2048x1536, 45° FOV, fundus photo:
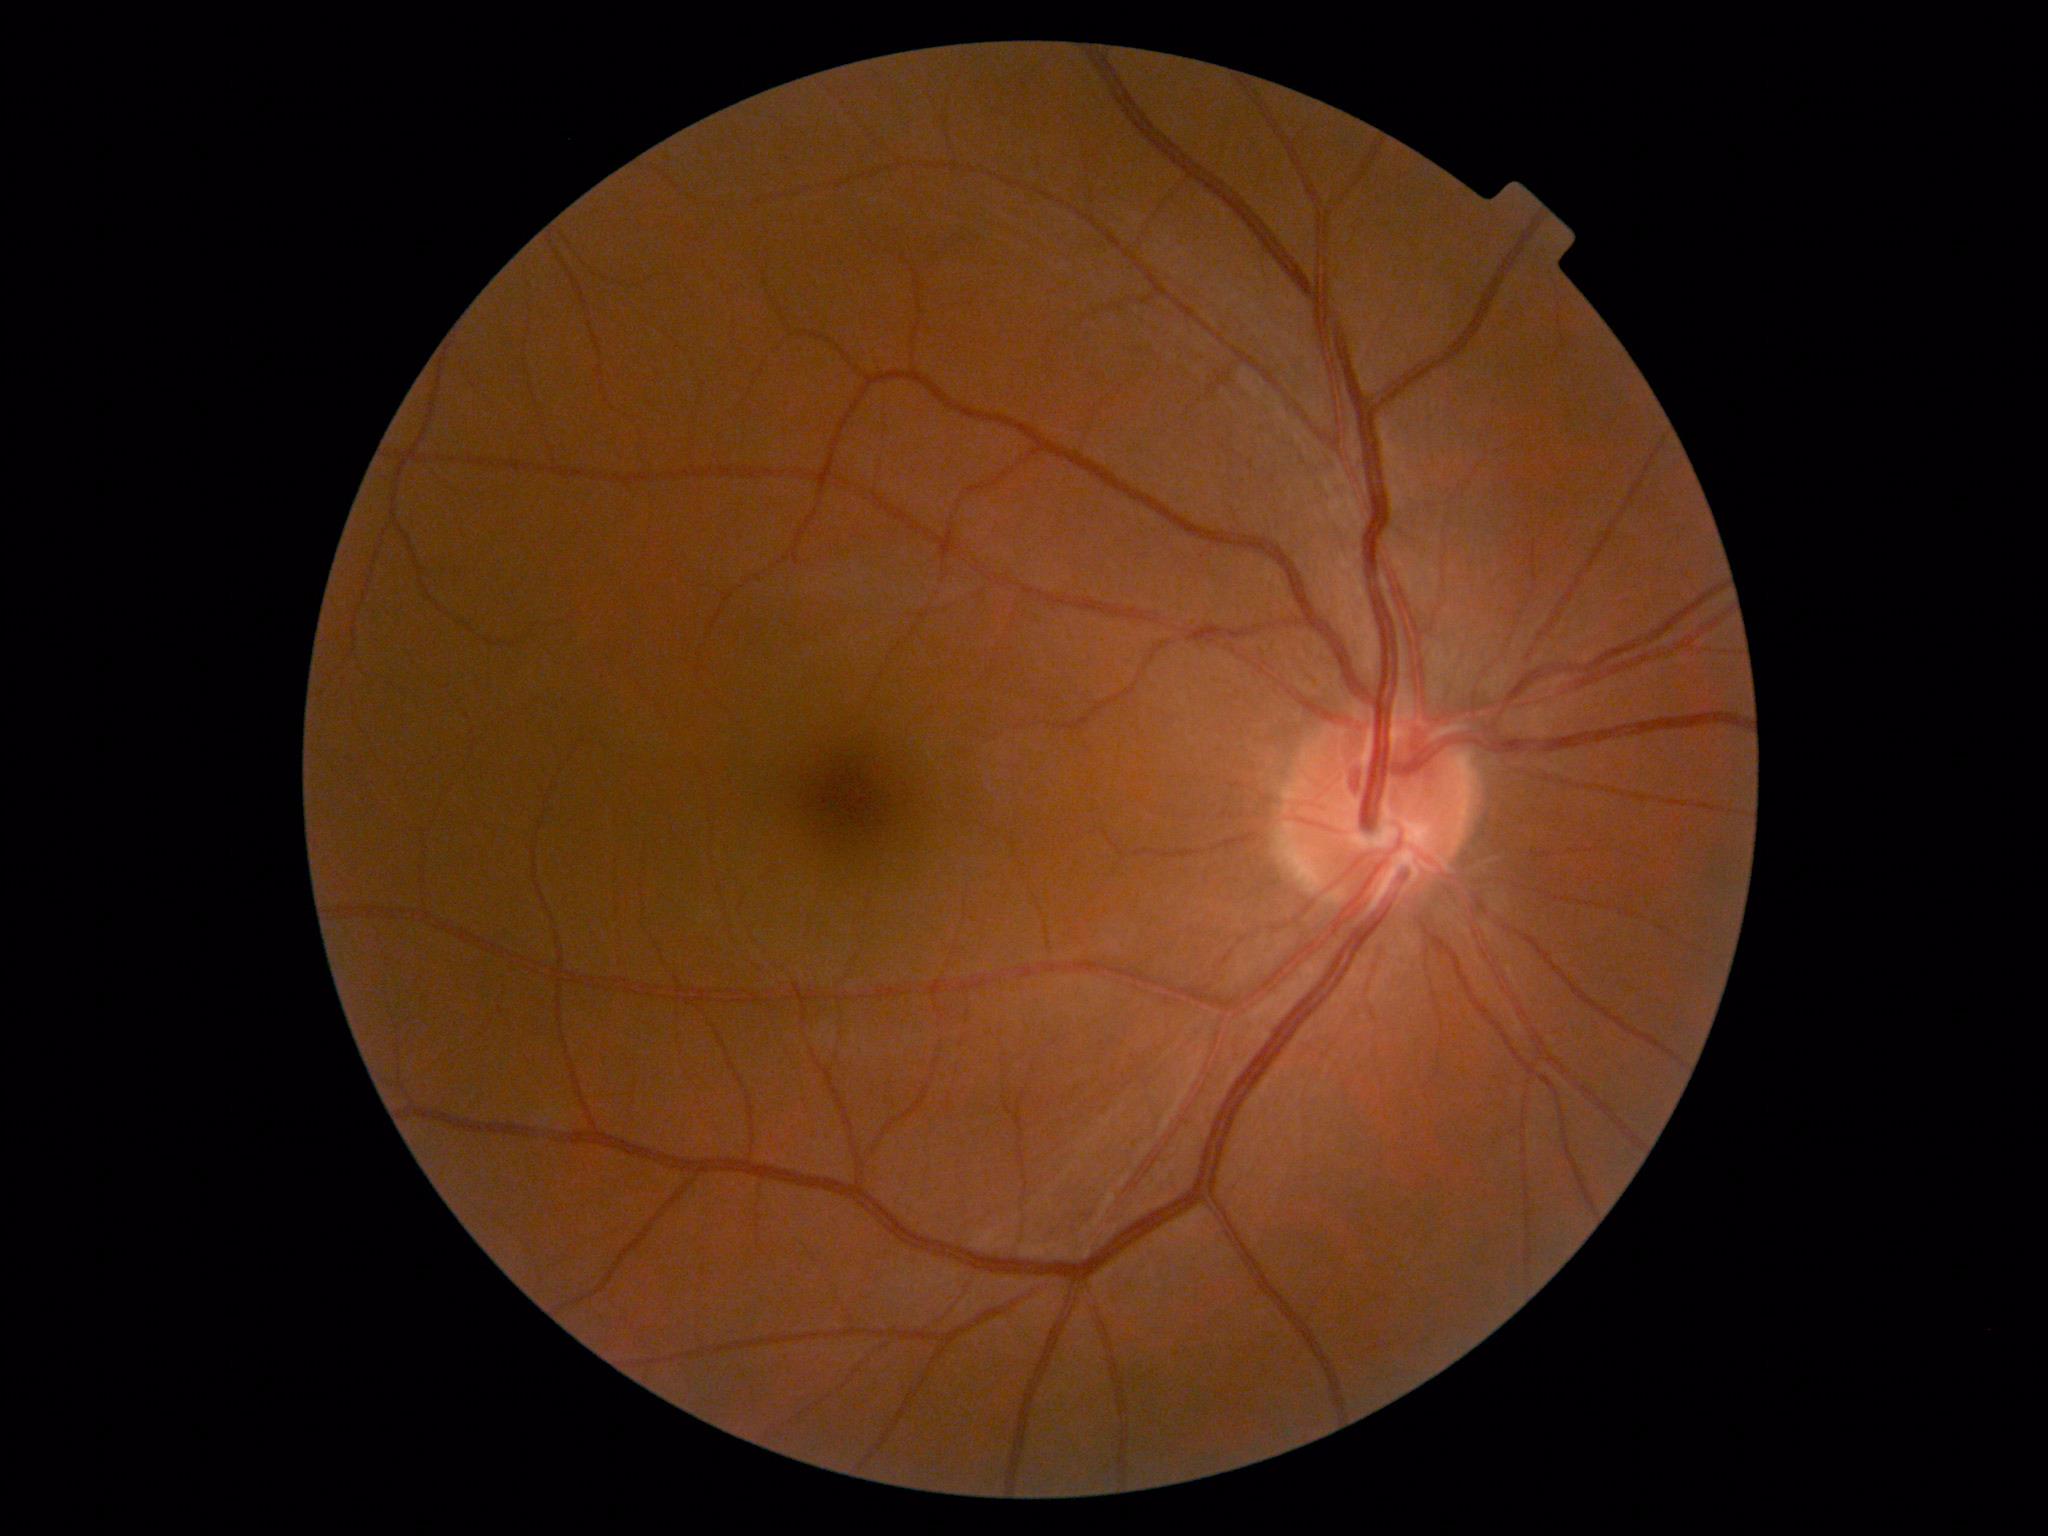
Annotations:
* diabetic retinopathy (DR): grade 0 (no apparent retinopathy)